45 degree fundus photograph · diabetic retinopathy graded by the modified Davis classification
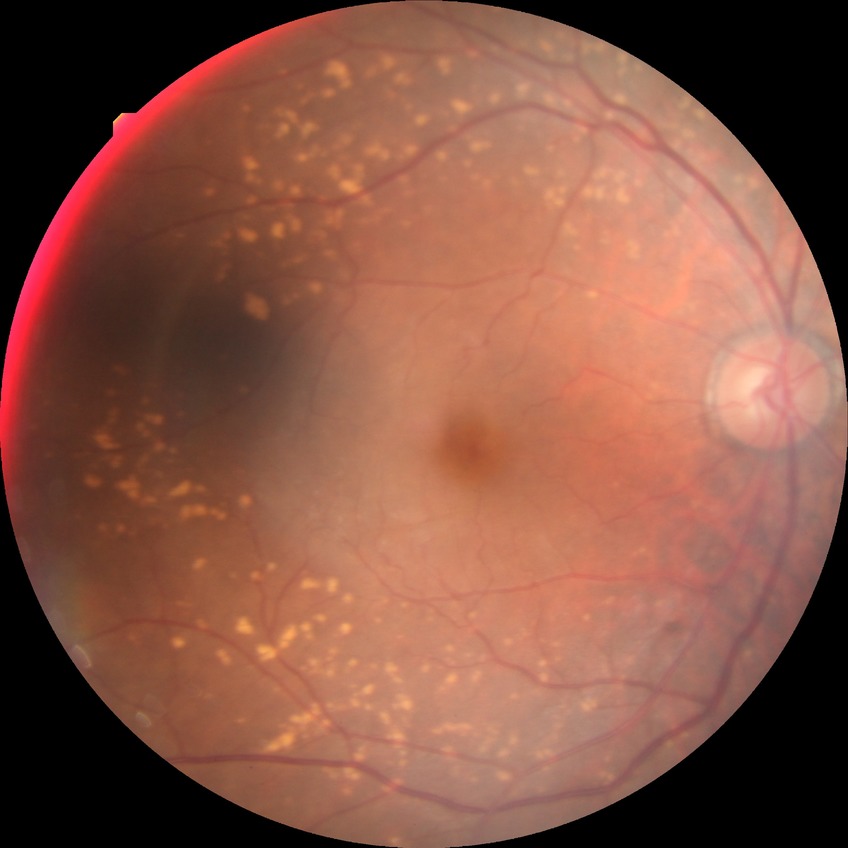
diabetic retinopathy stage: simple diabetic retinopathy.